Image size 848x848: 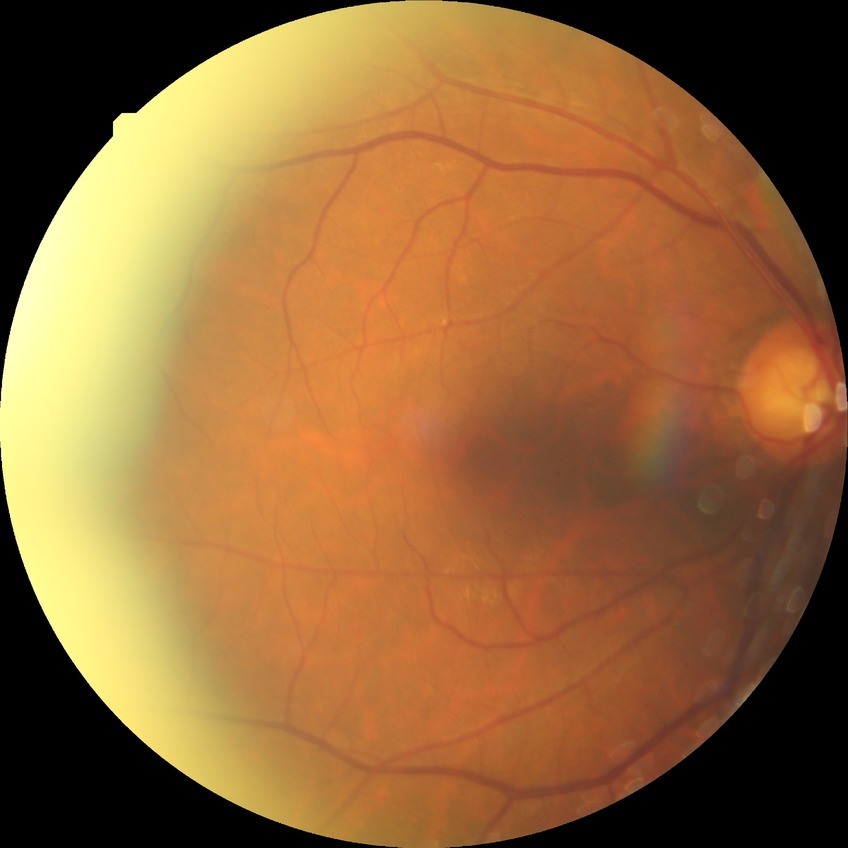 DR is SDR.